CFP. 1659 x 2212 pixels.
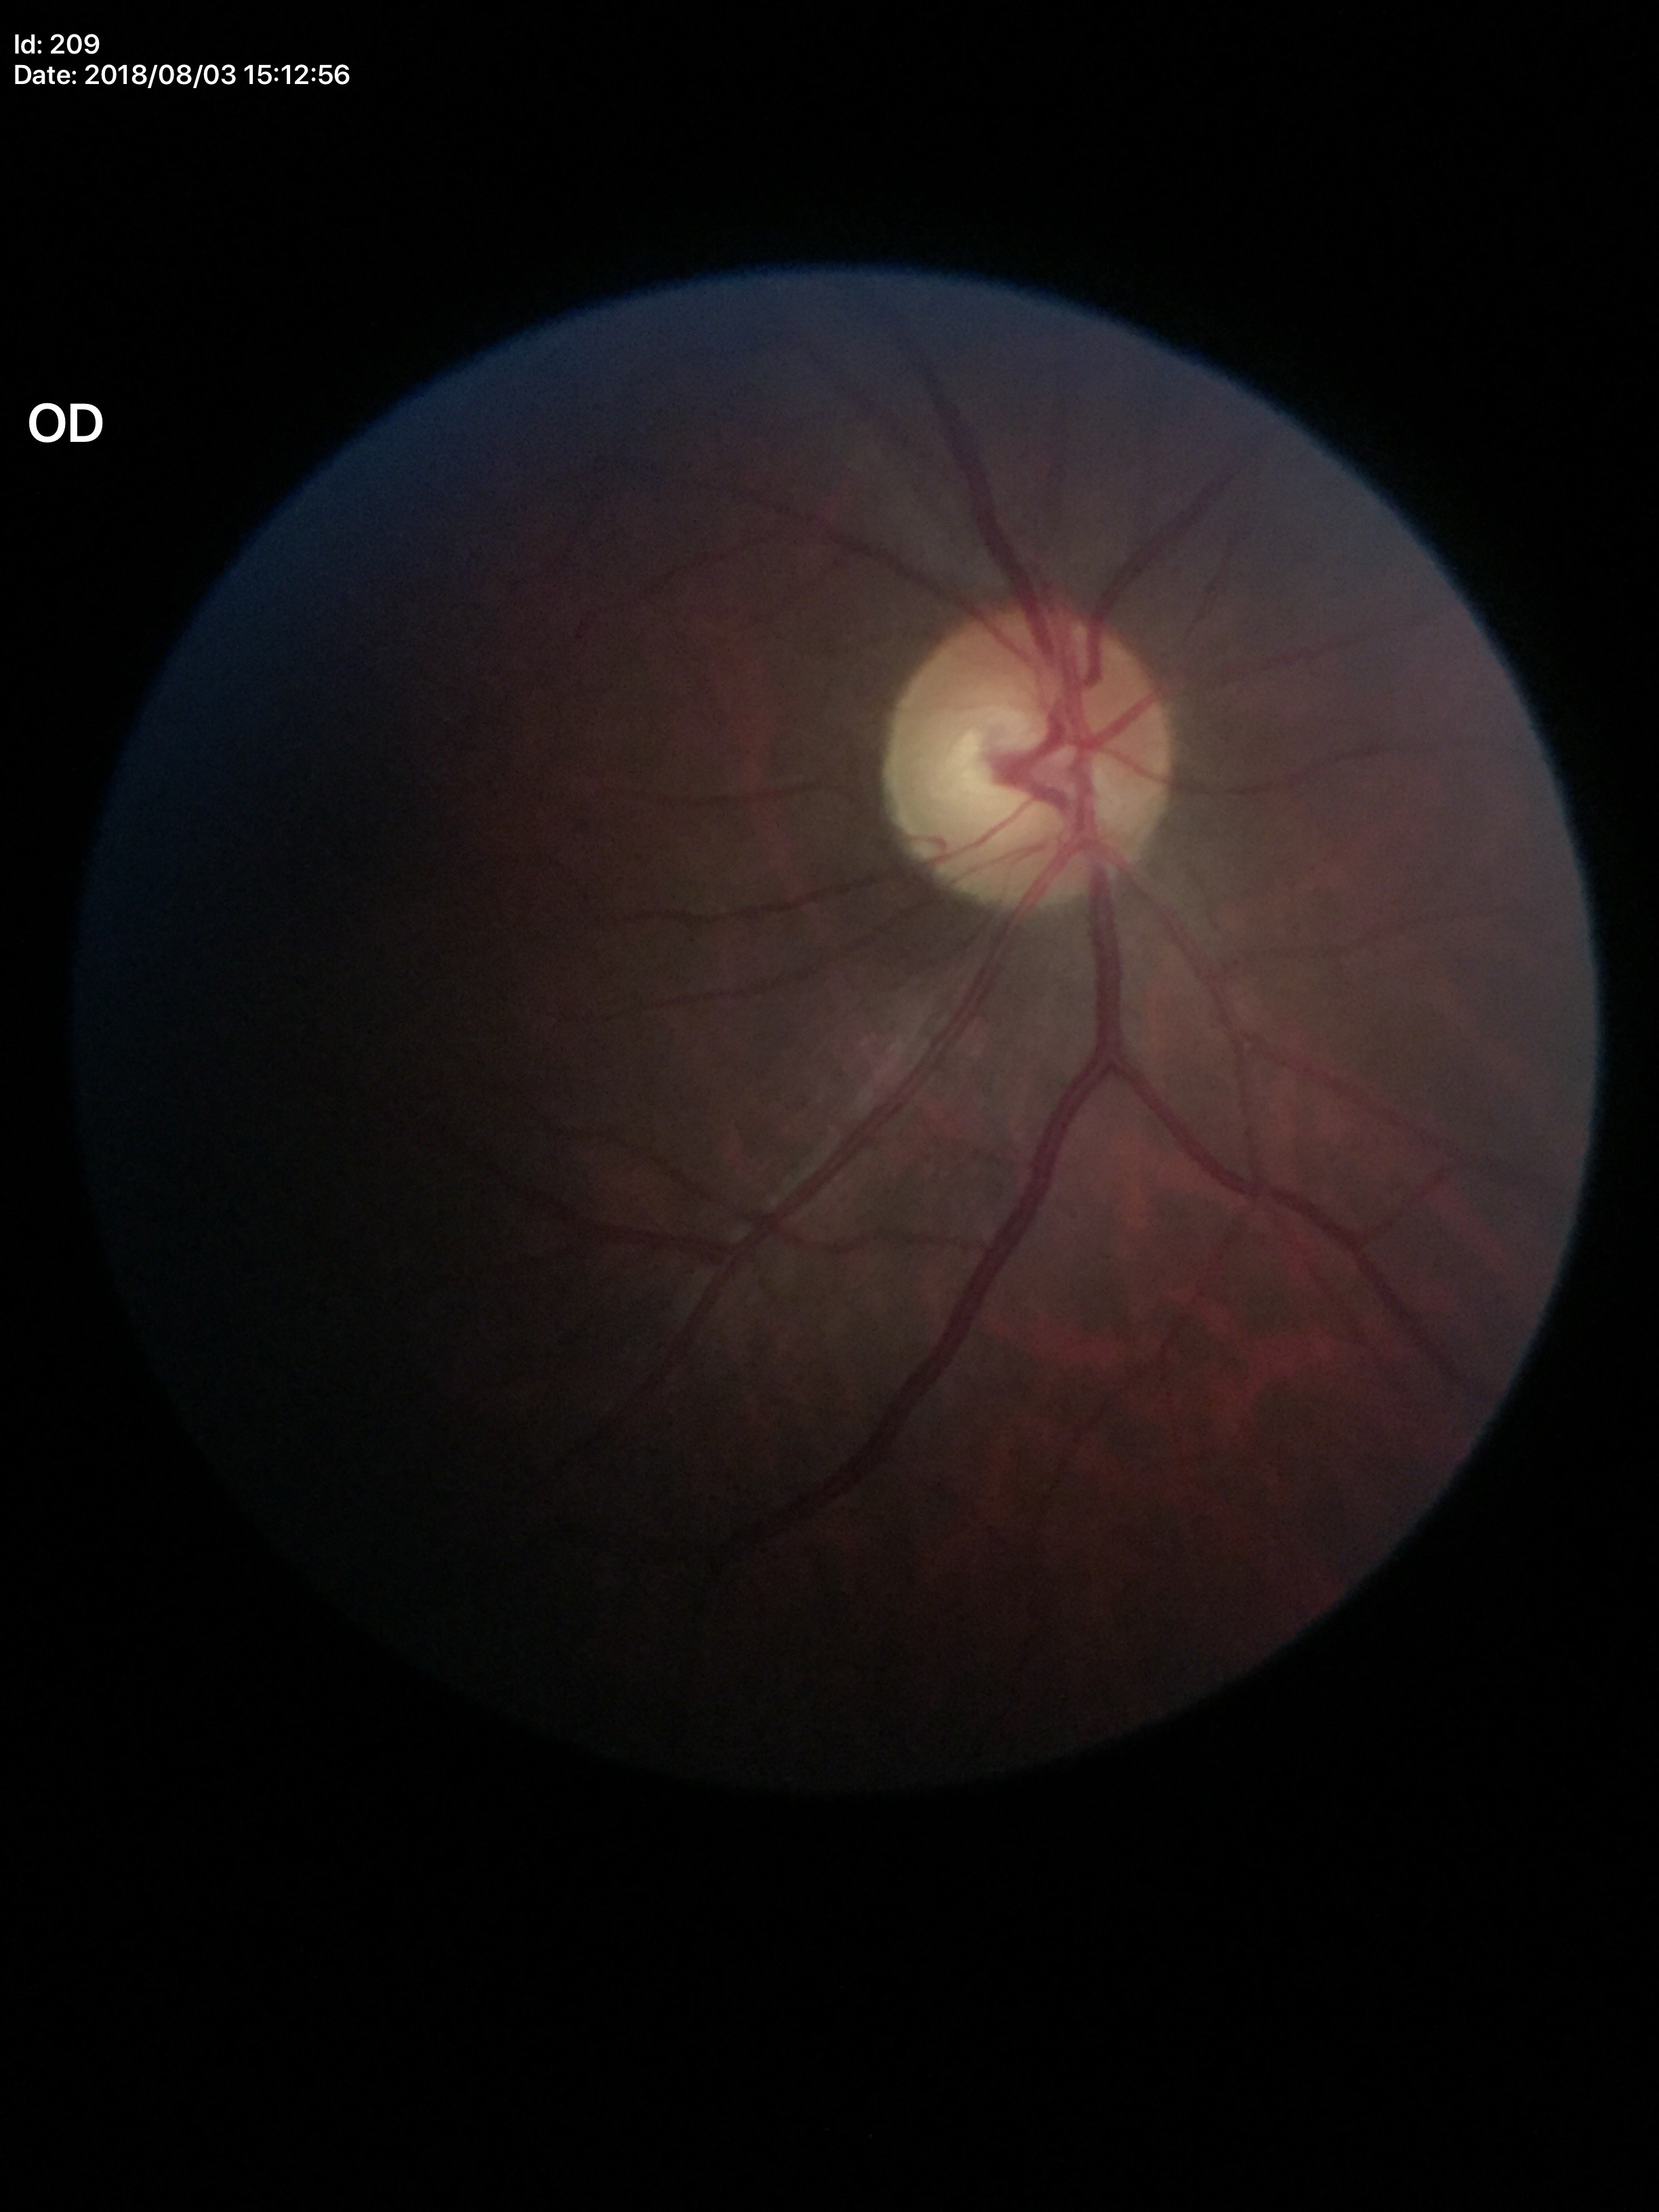
Glaucoma screening impression: suspect. Vertical cup-to-disc ratio of 0.61.